45° FOV. 2352 by 1568 pixels. Fundus photo: 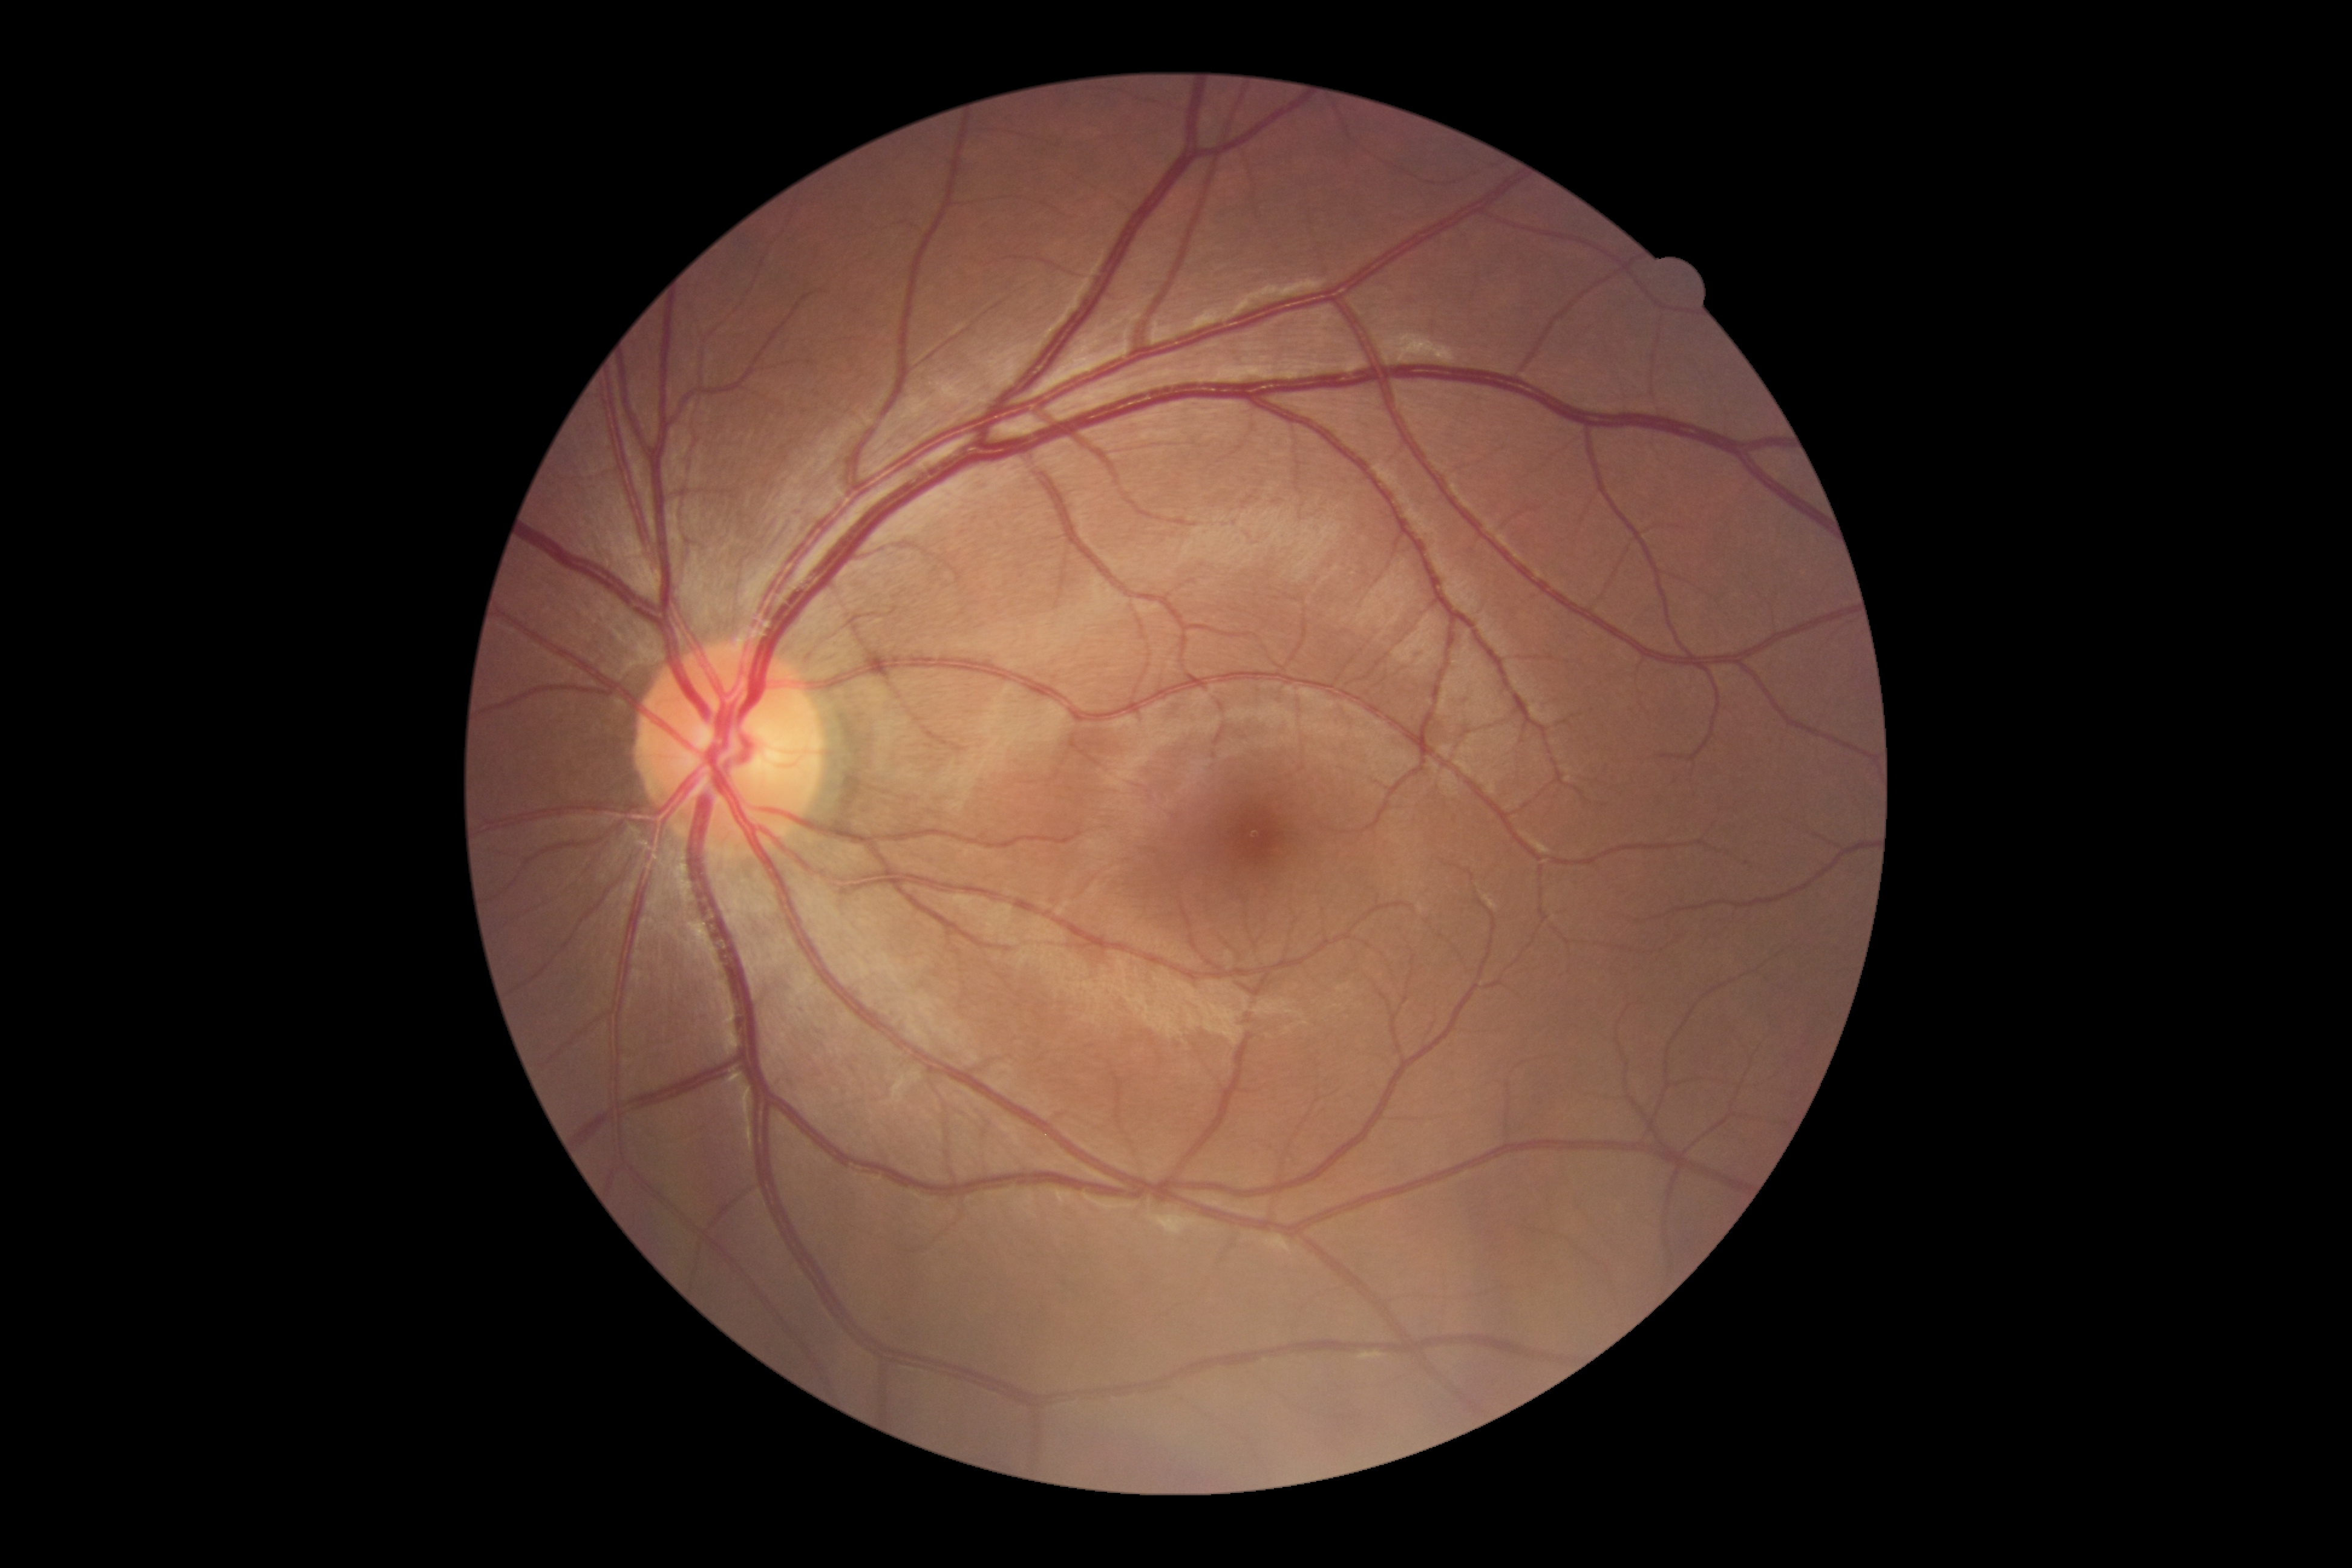

diabetic retinopathy grade@no apparent diabetic retinopathy (0).